Phoenix ICON, 100° FOV. Wide-field fundus image from infant ROP screening.
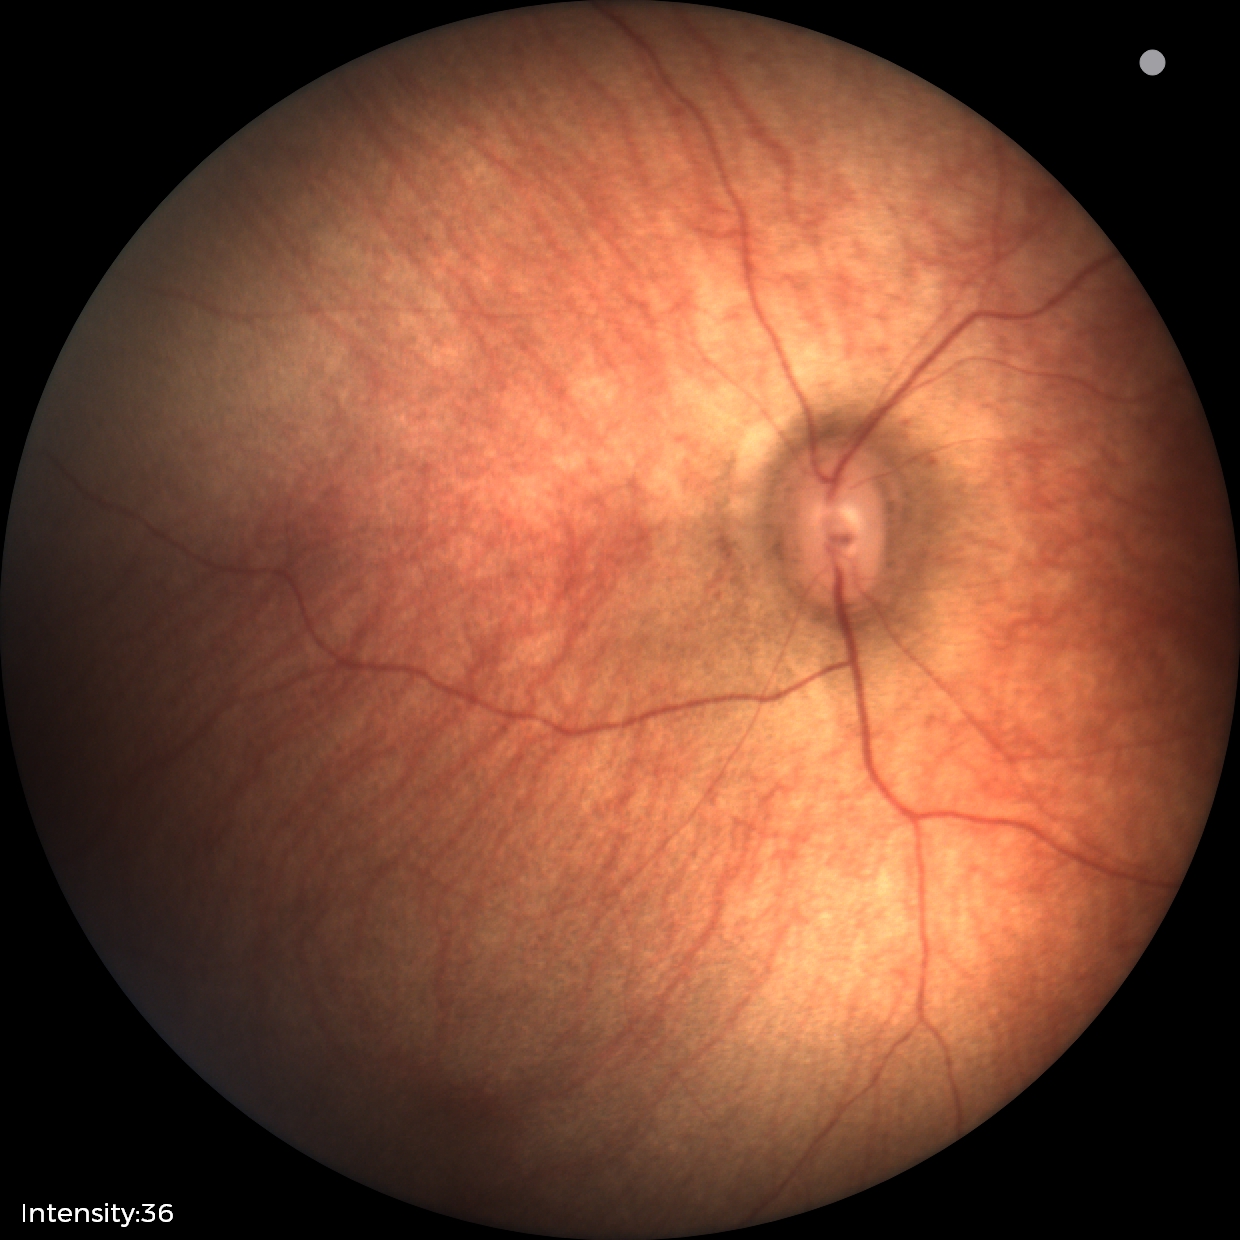 Examination with physiological retinal findings.